Graded on the modified Davis scale — 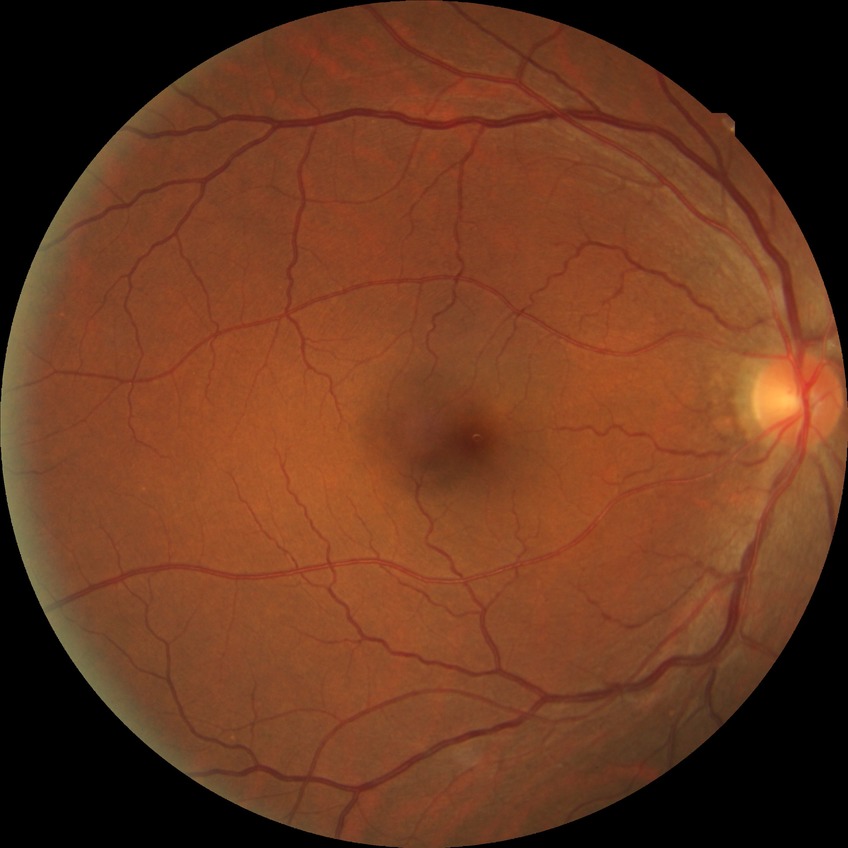 Retinopathy stage is no diabetic retinopathy.